2352x1568, 45° FOV
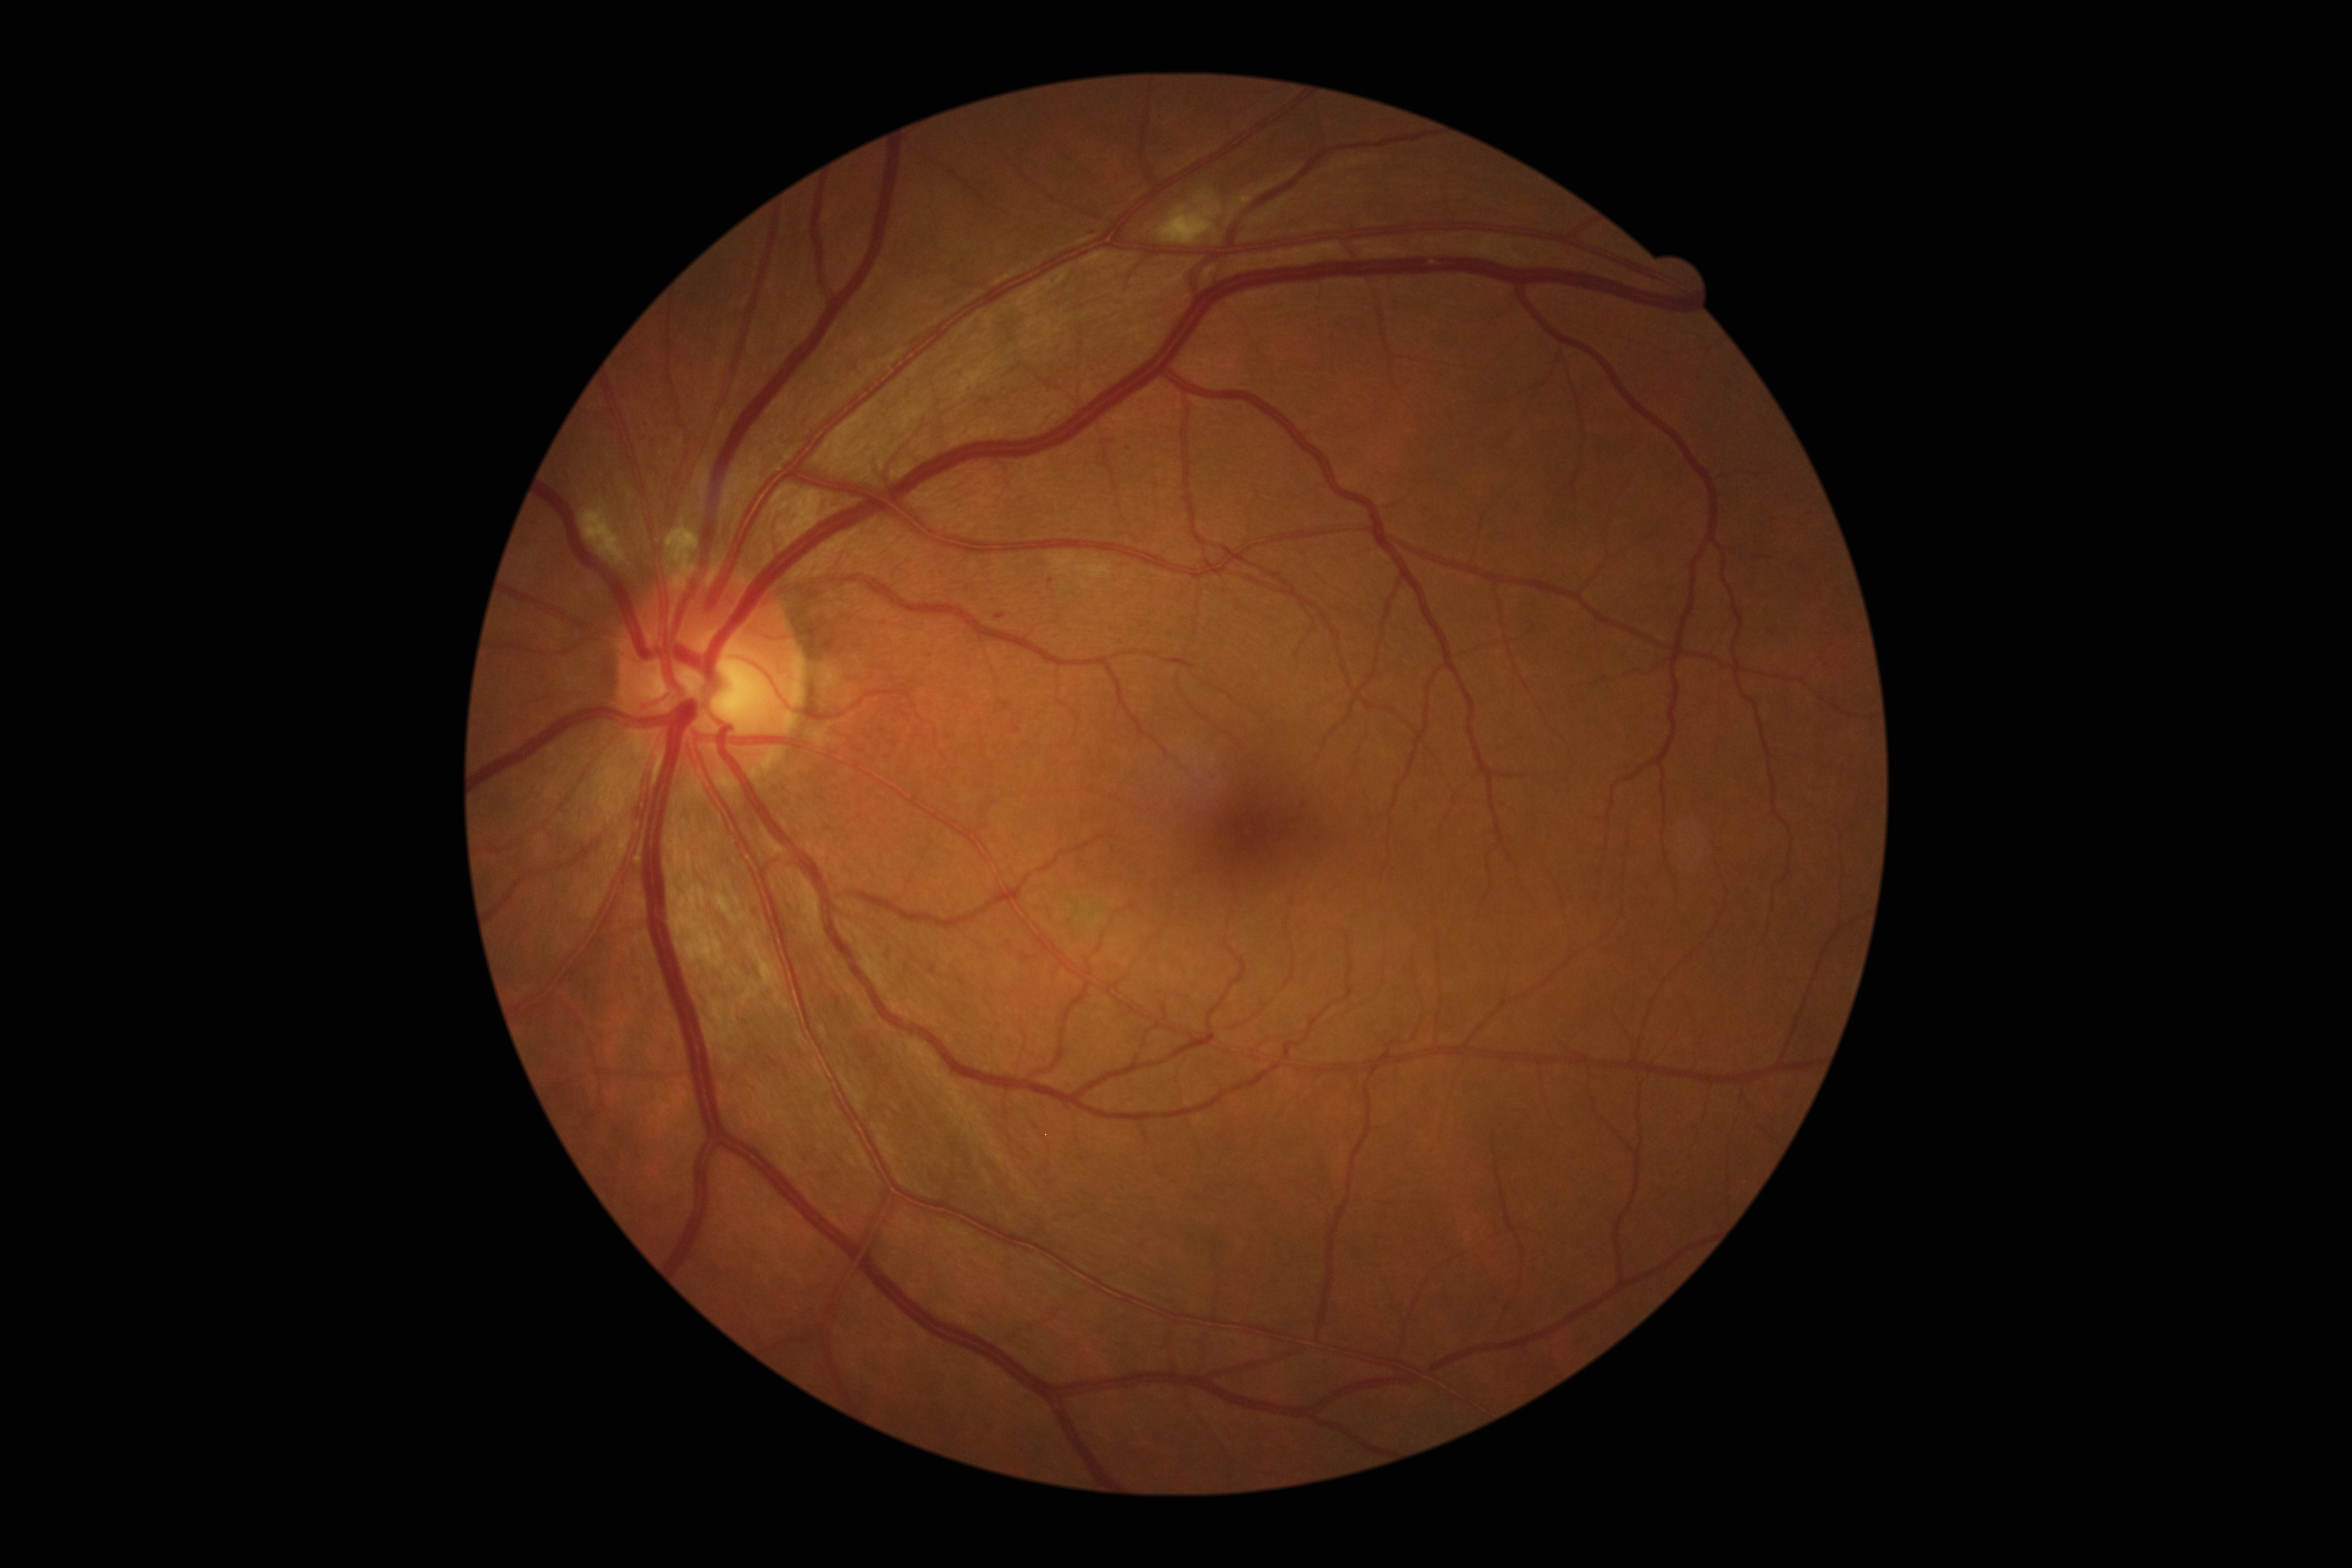
DR stage: grade 2.